45-degree field of view: 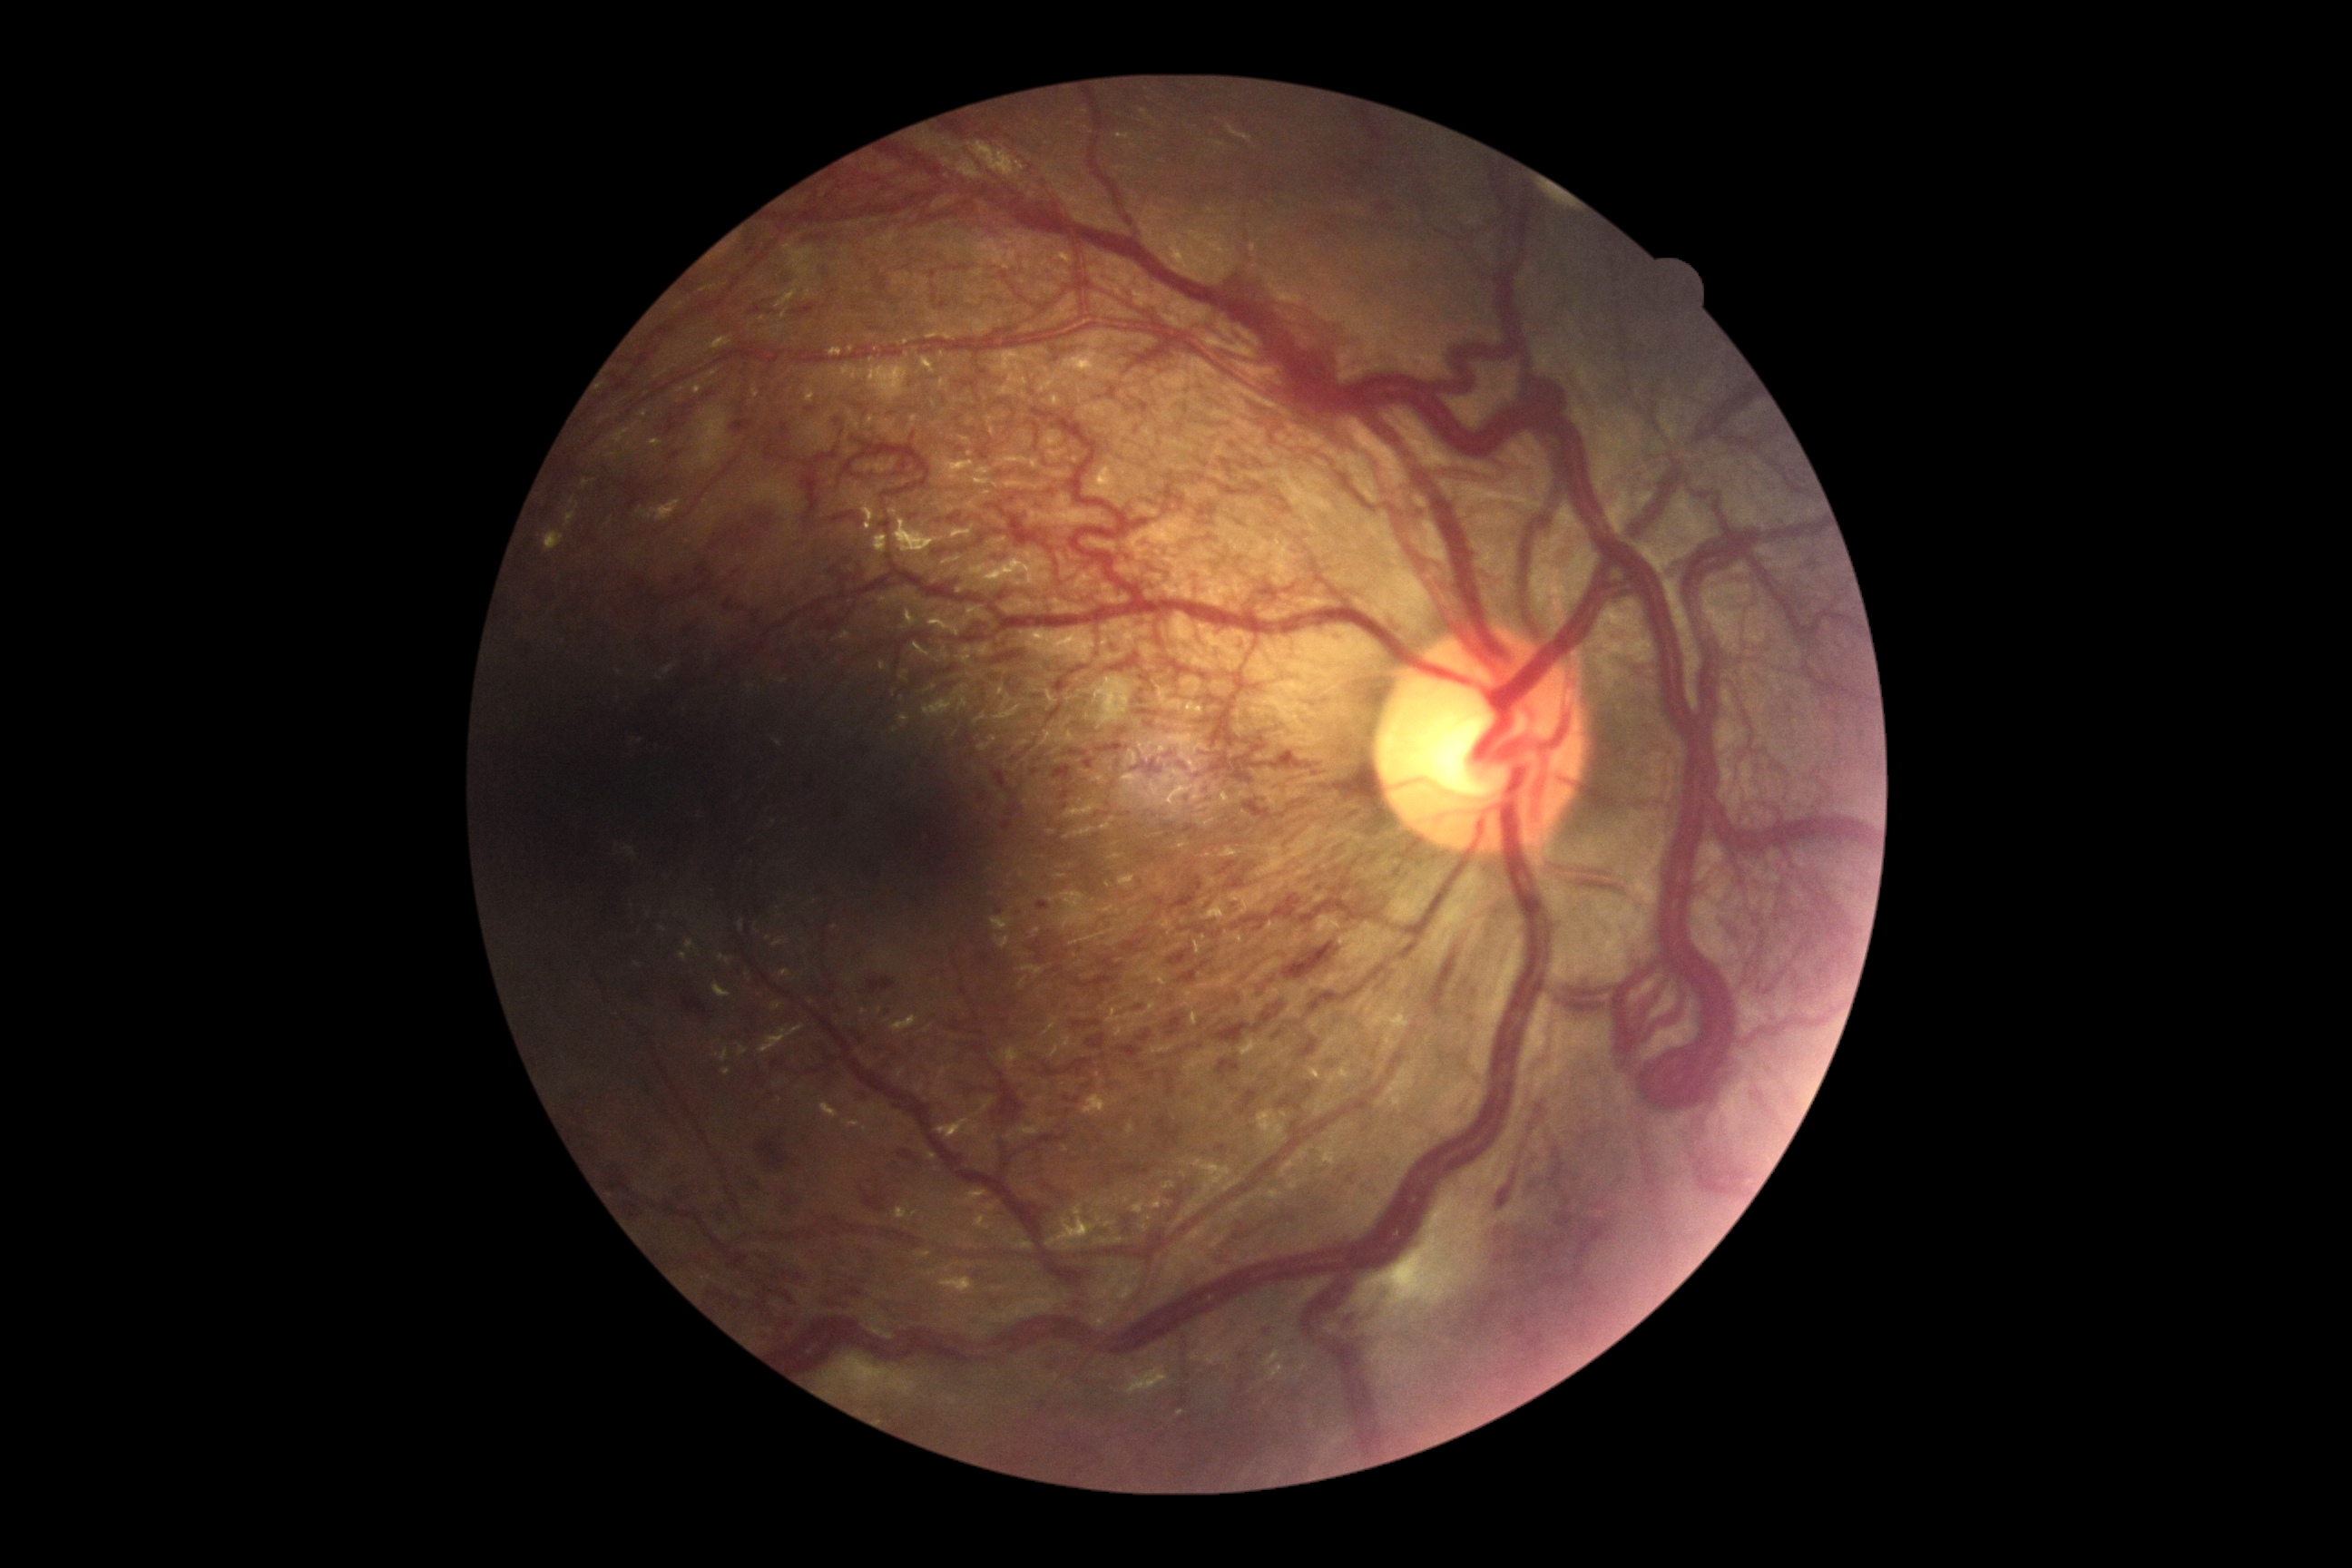 DR stage=PDR (grade 4).